FOV: 45 degrees · 2212 x 1659 pixels: 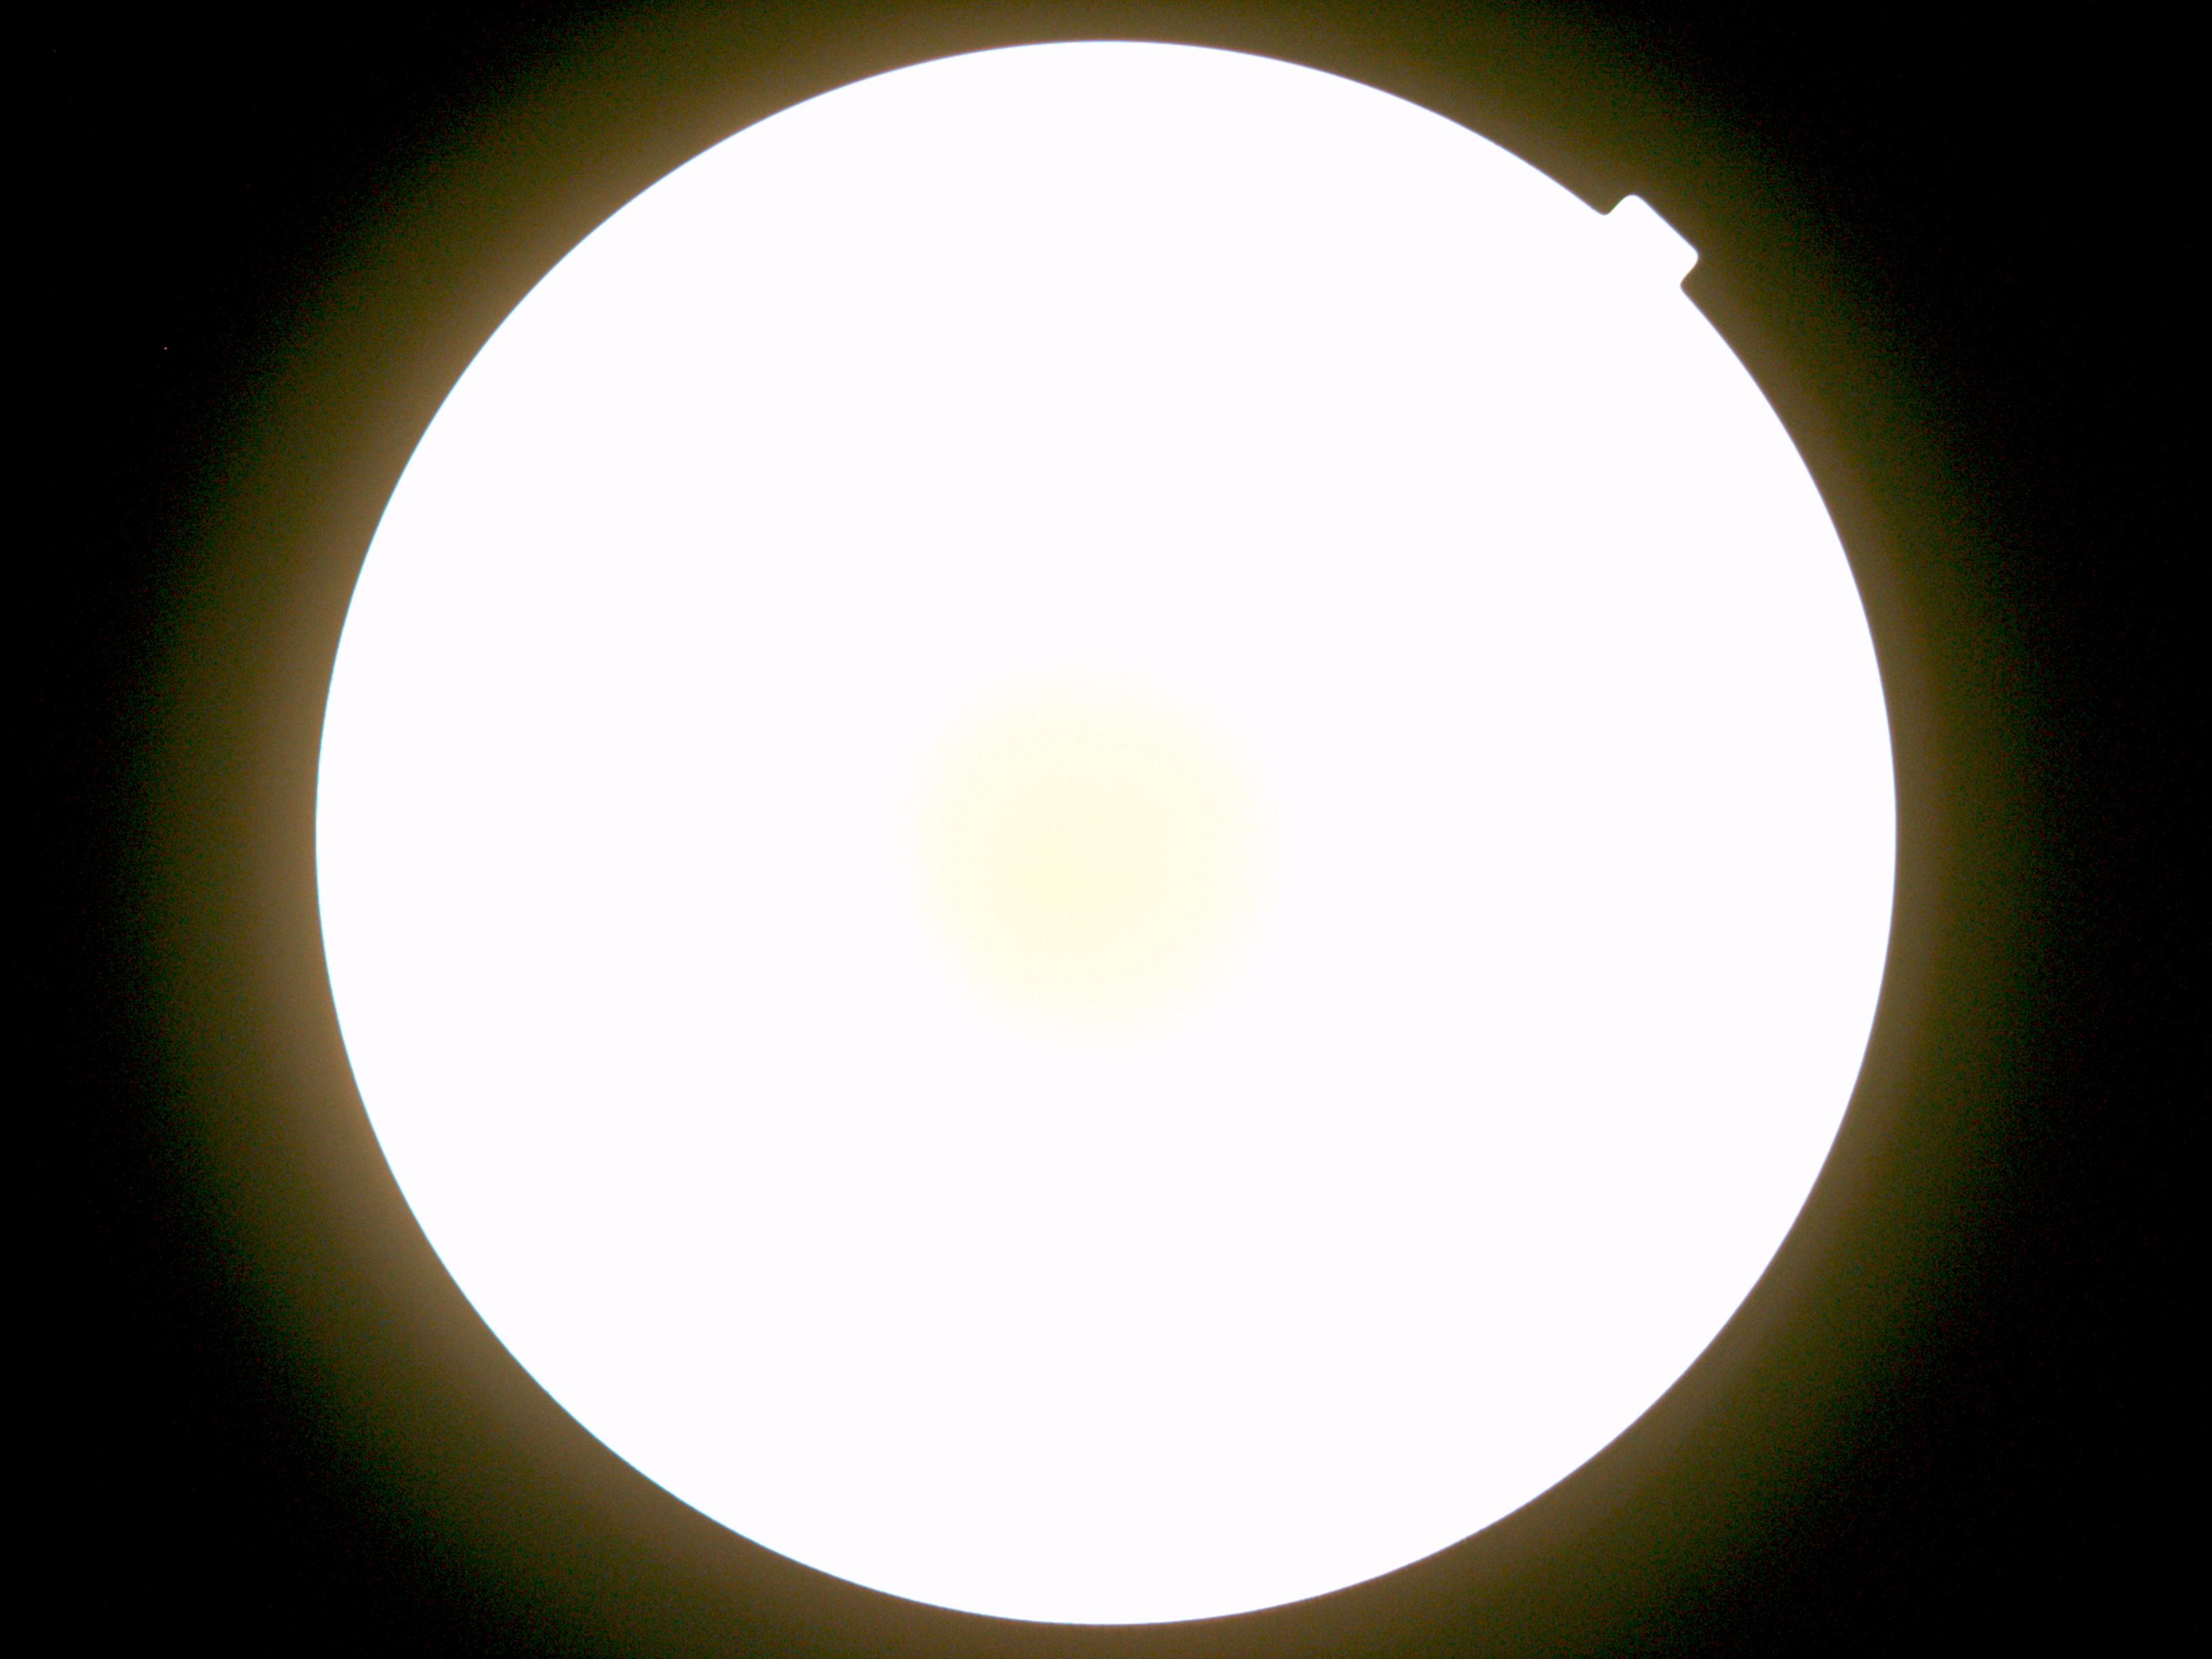 The image cannot be graded for diabetic retinopathy.
Diabetic retinopathy severity is ungradable.